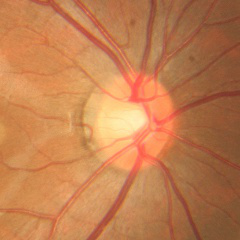 Q: Is glaucoma present?
A: No glaucoma.